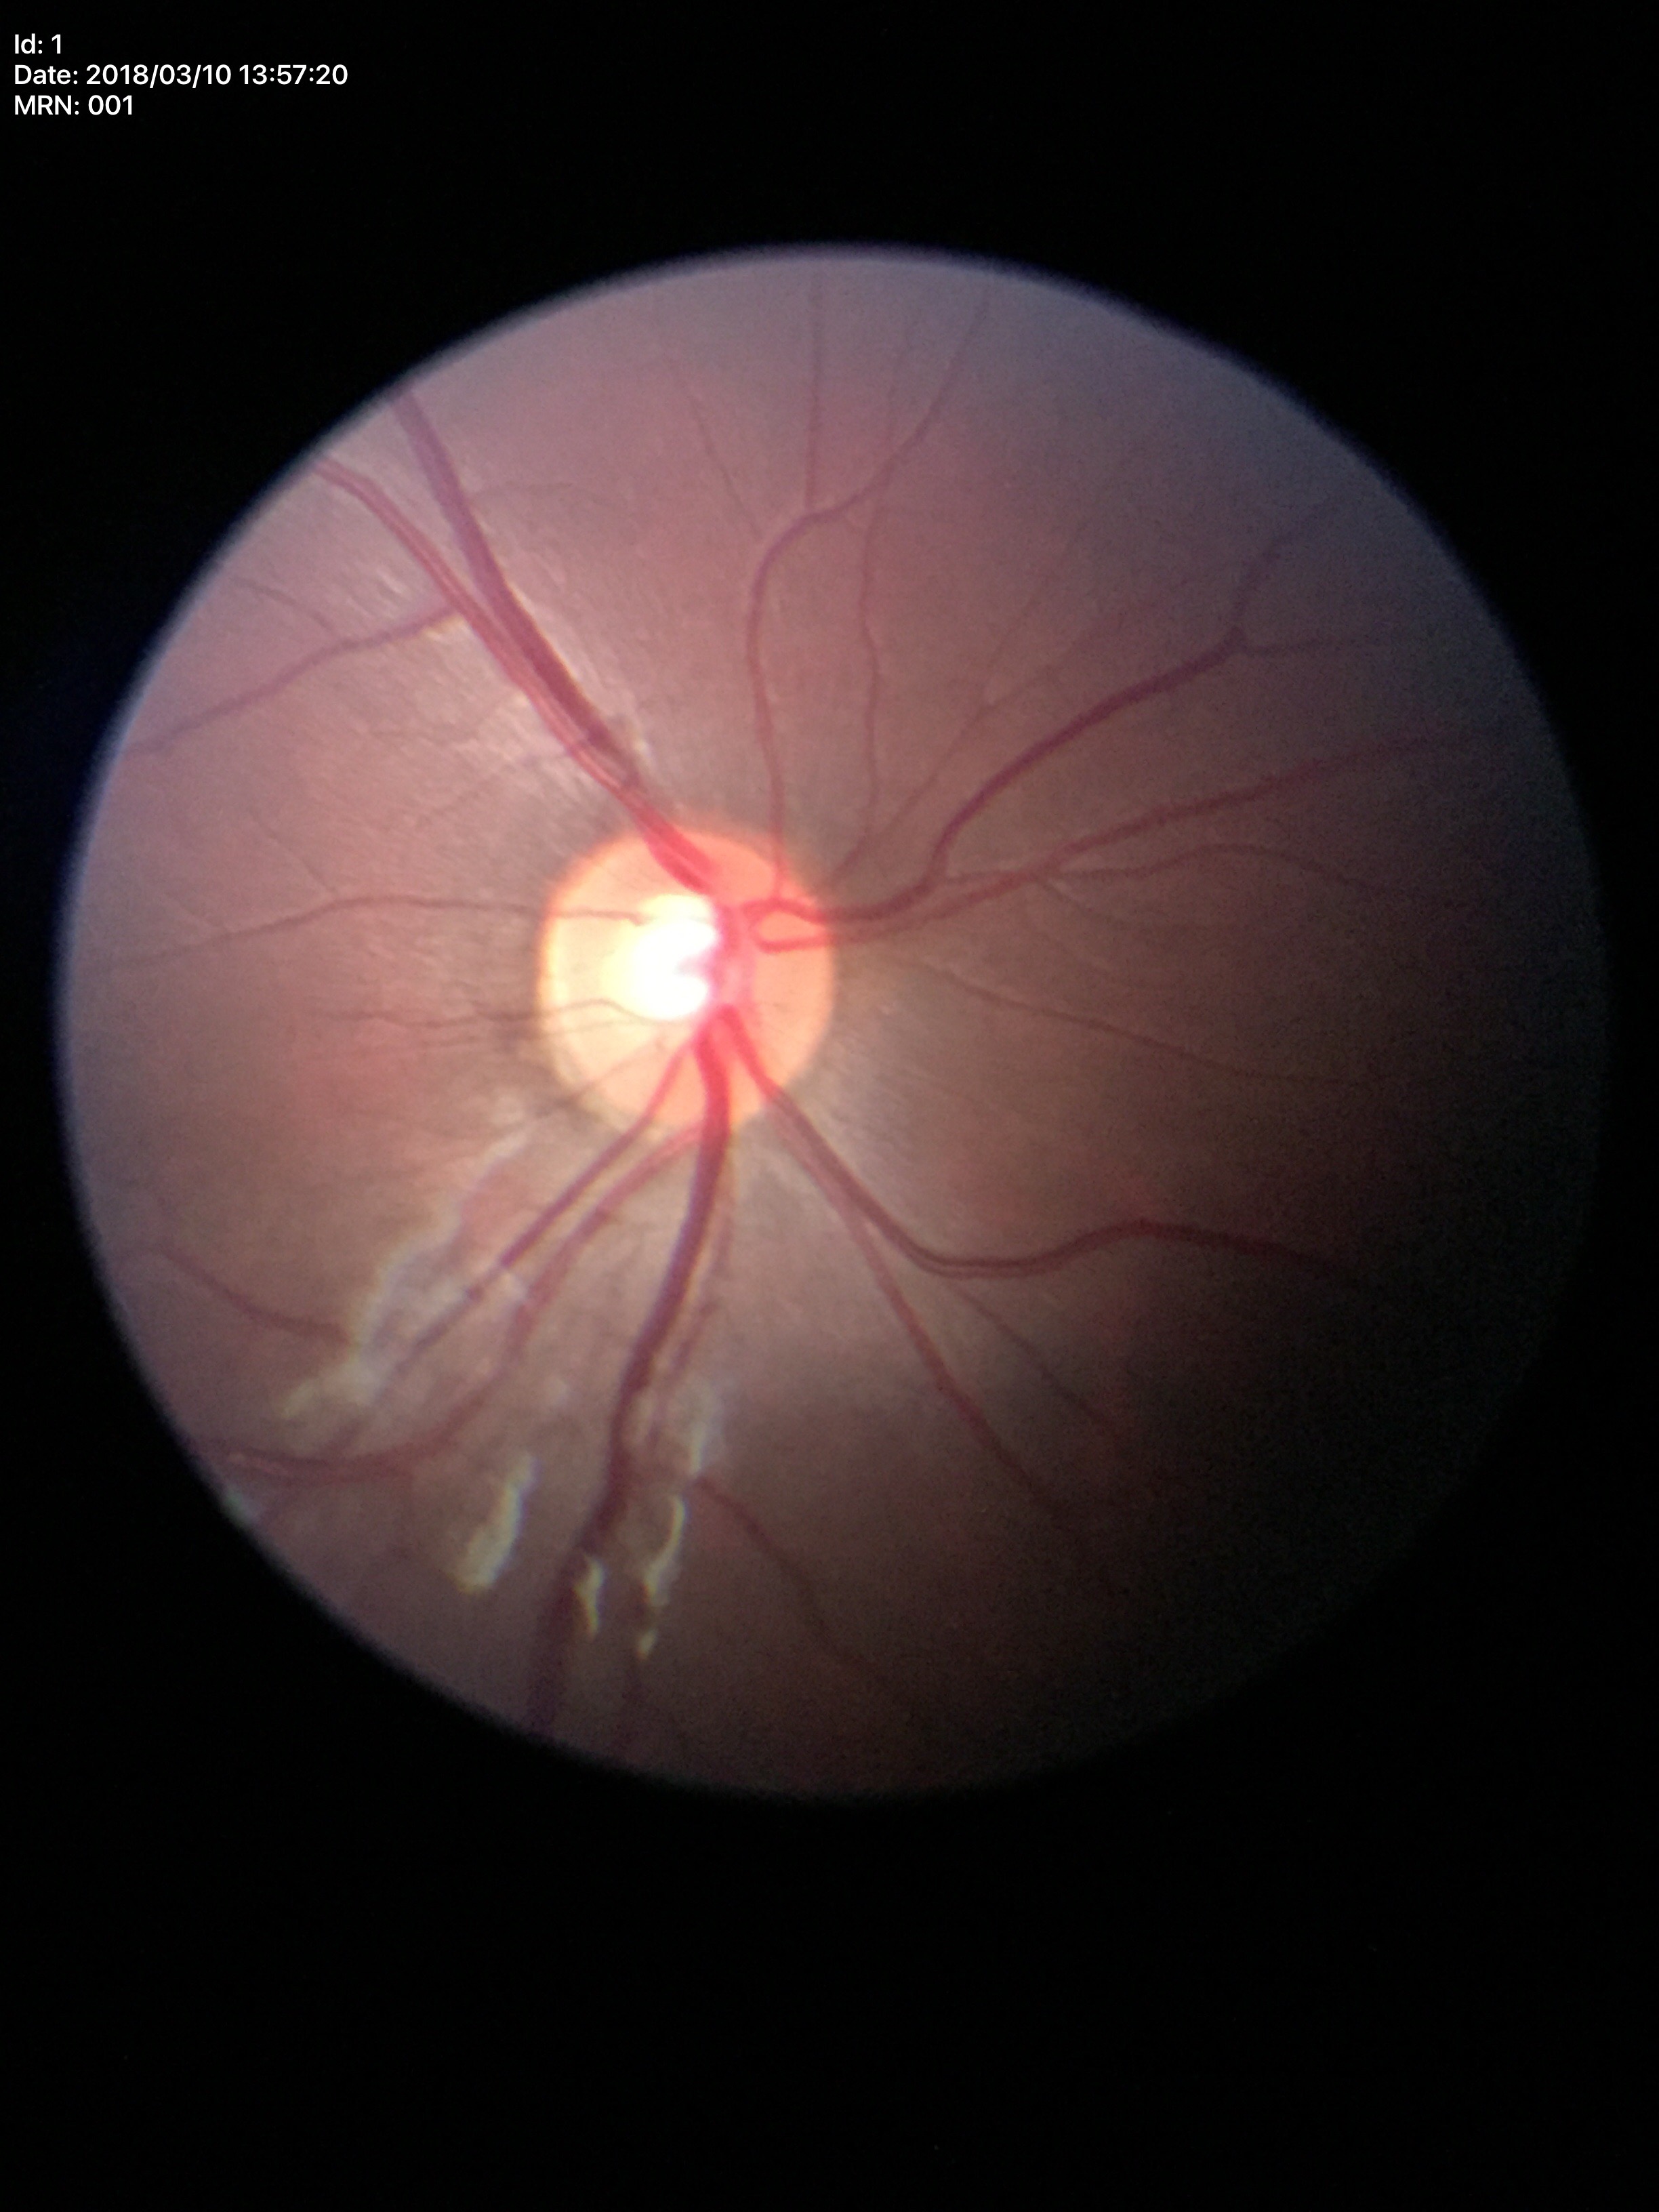
Annotations:
* vertical cup-to-disc ratio (VCDR) · 0.53
* Glaucoma screening · no suspicious findings